640 by 480 pixels · pediatric wide-field fundus photograph.
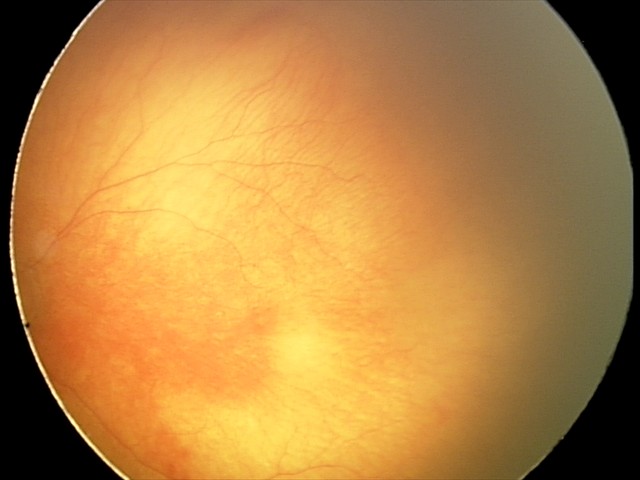

Plus disease: present, impression: A-ROP (aggressive ROP) — rapidly progressive severe ROP with prominent plus disease, often without classic stage progression.